NIDEK AFC-230. Davis DR grading
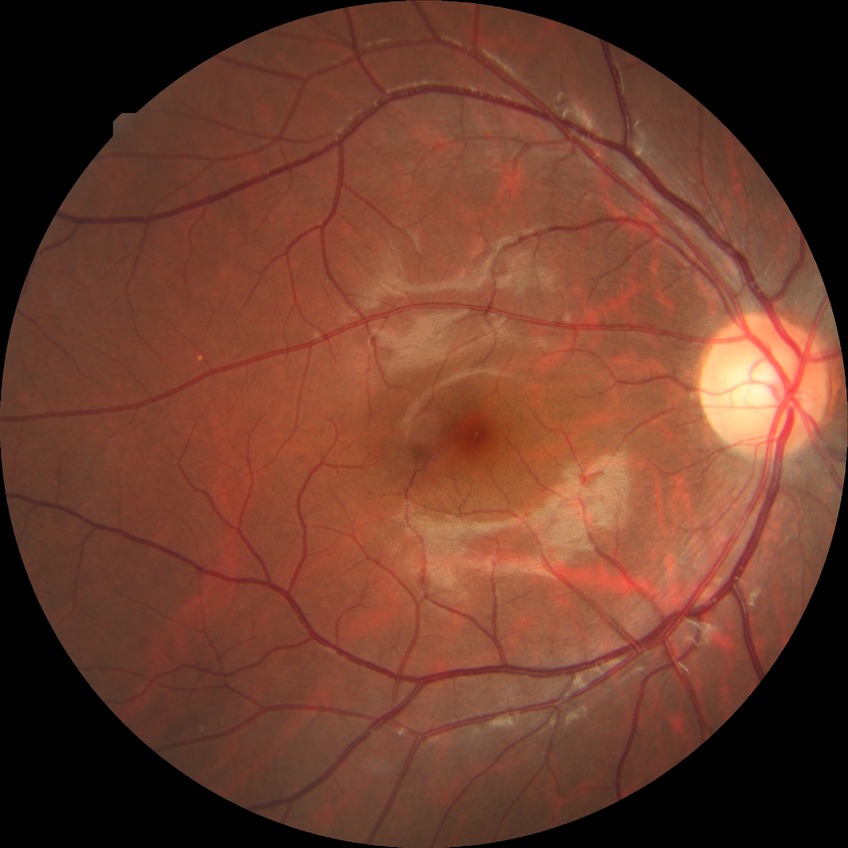

Modified Davis classification: no diabetic retinopathy.